2352x1568px — 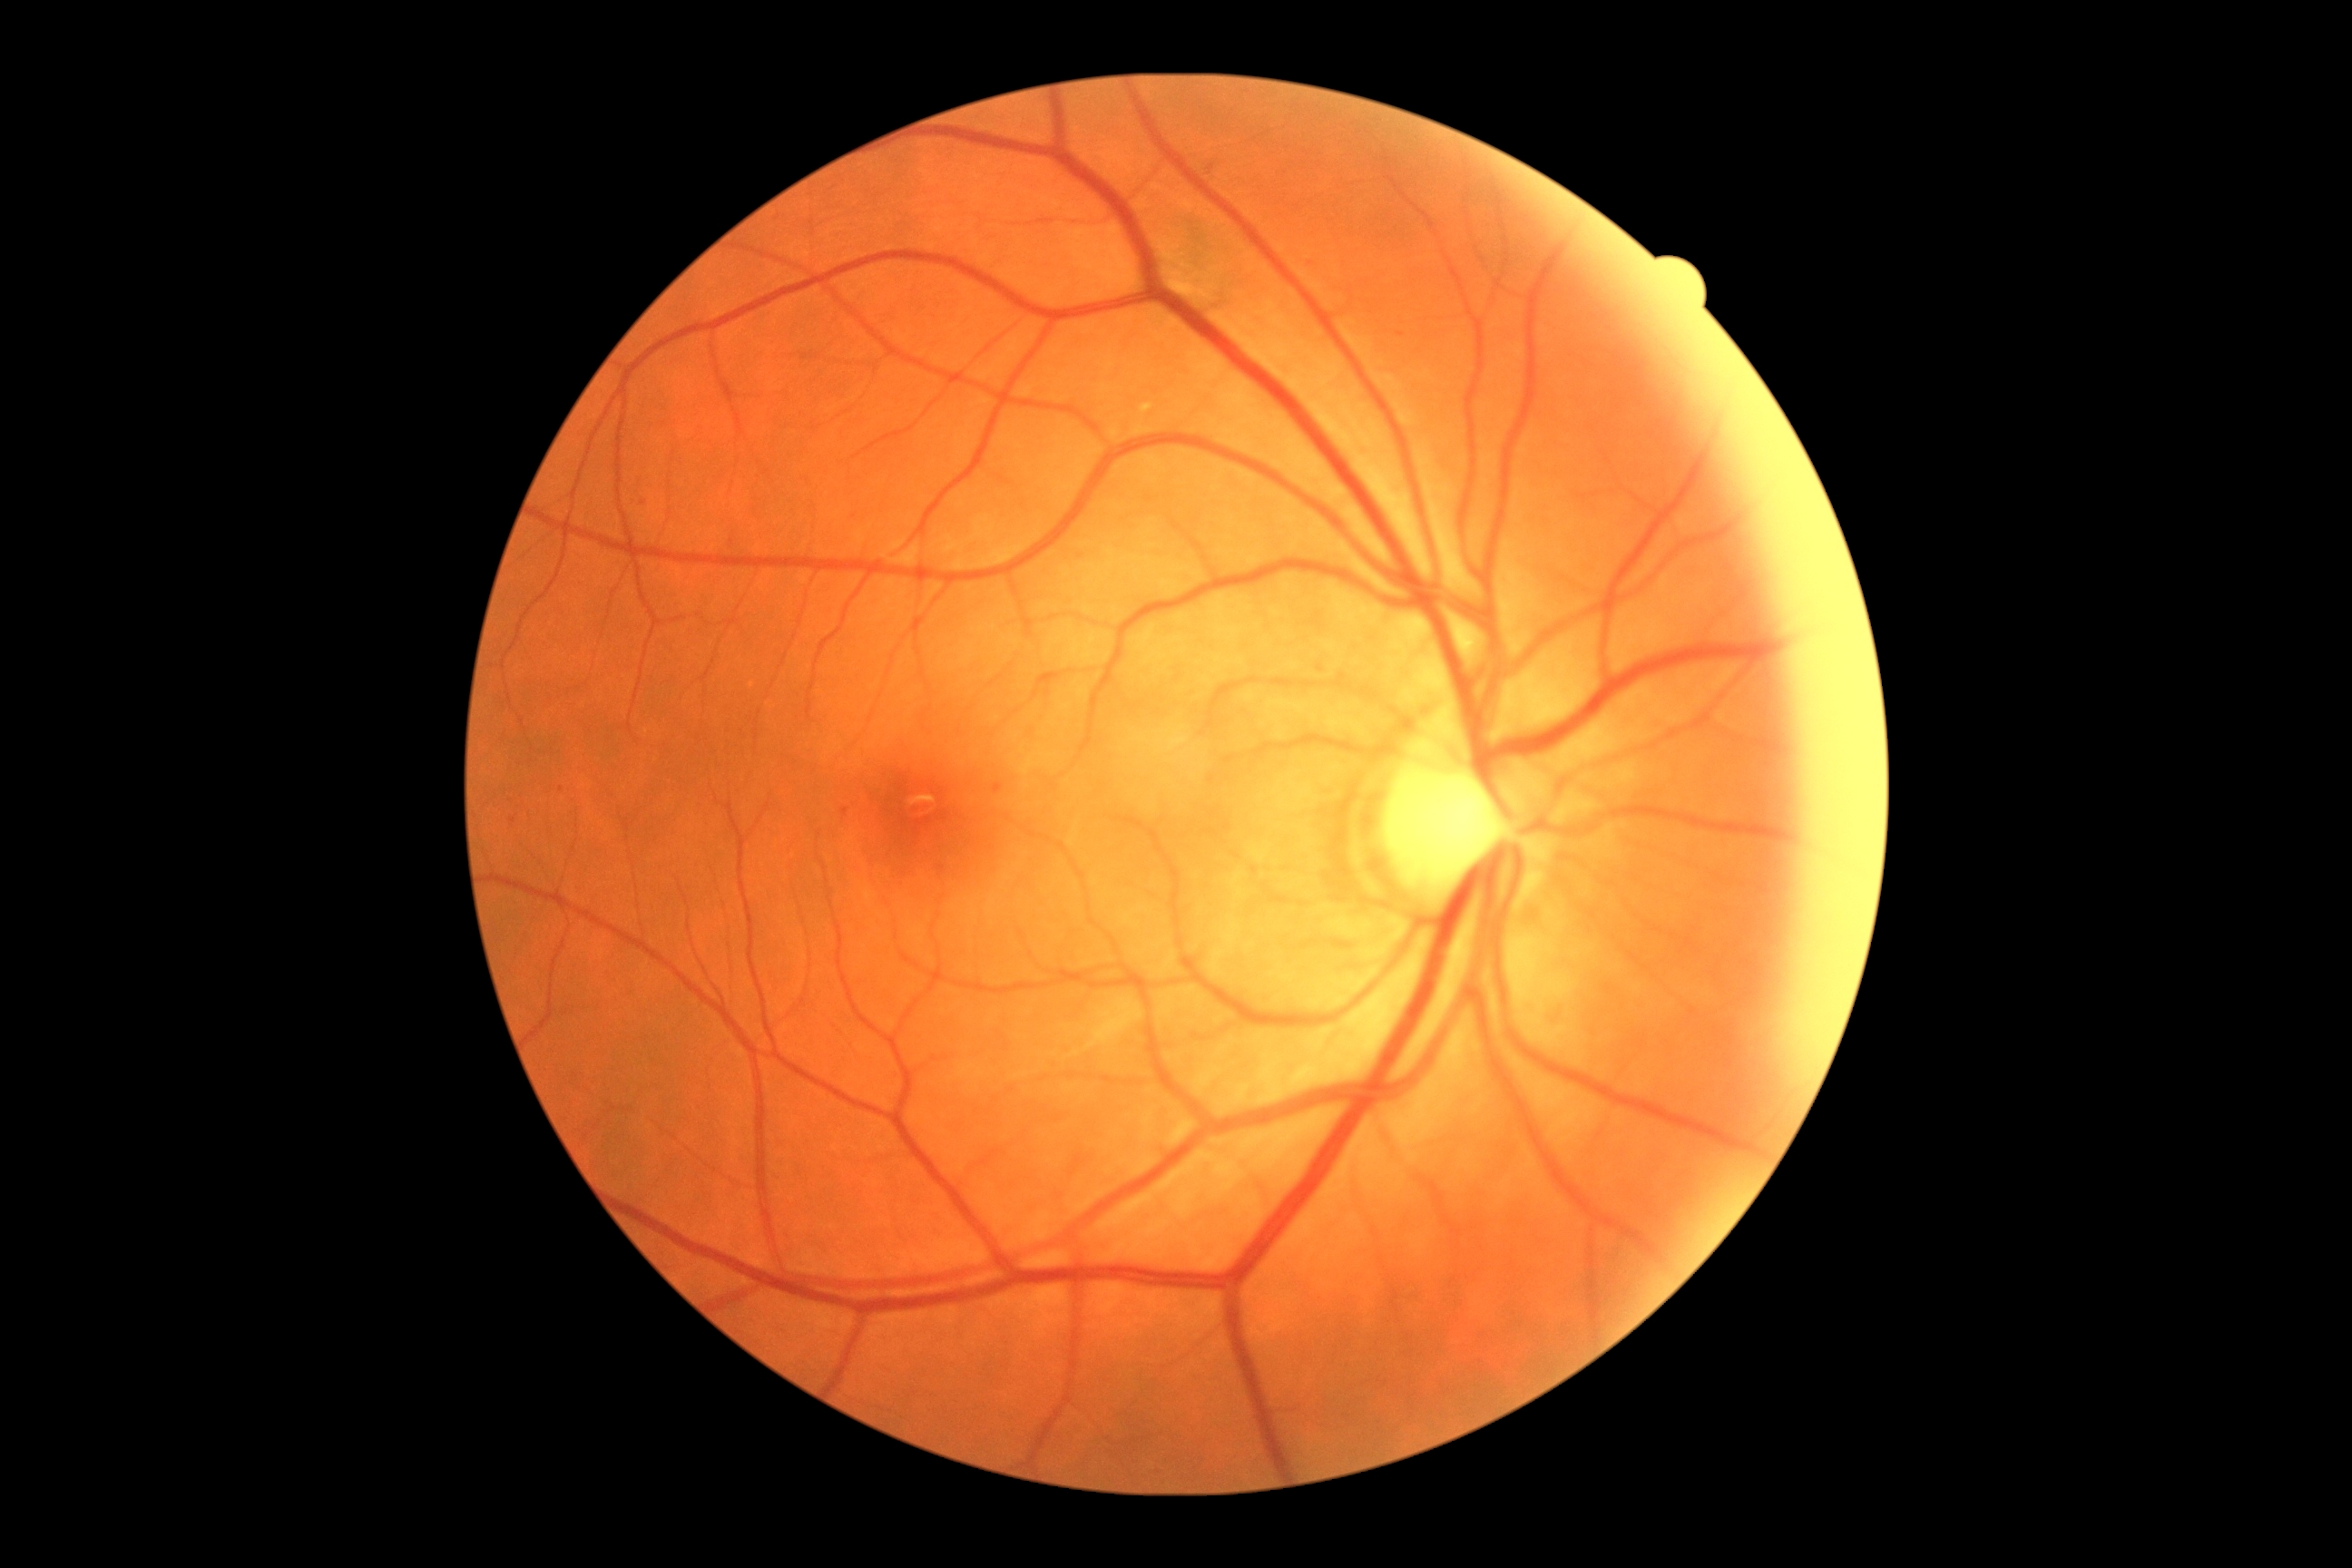
DR severity: 1